848 by 848 pixels, CFP, NIDEK AFC-230
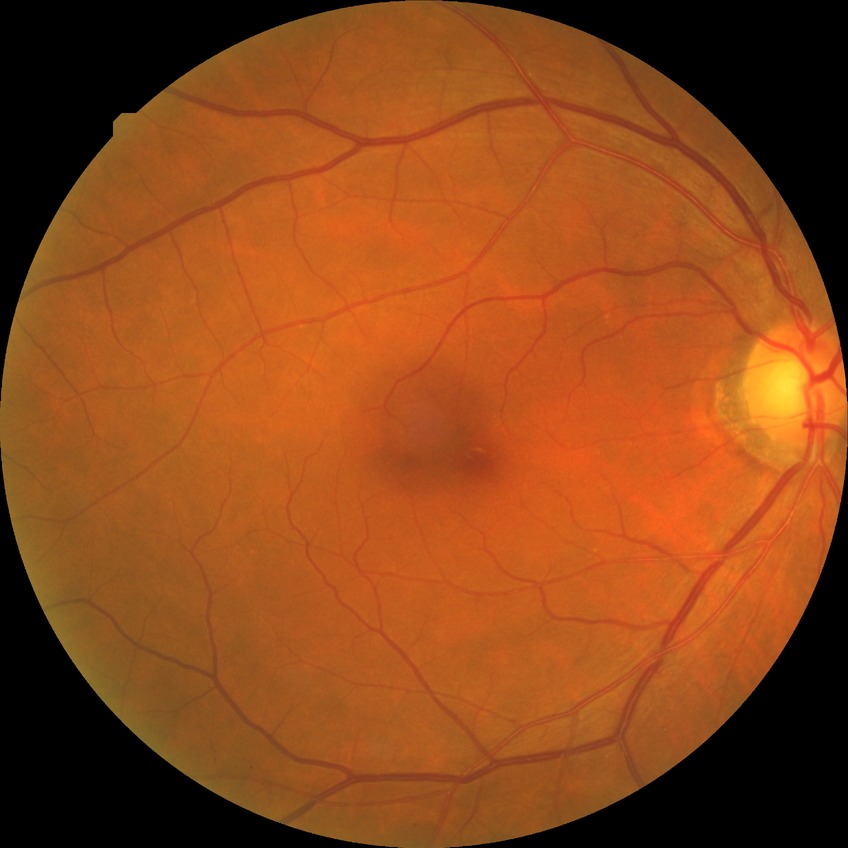

DR class: non-proliferative diabetic retinopathy.
Modified Davis classification is simple diabetic retinopathy.